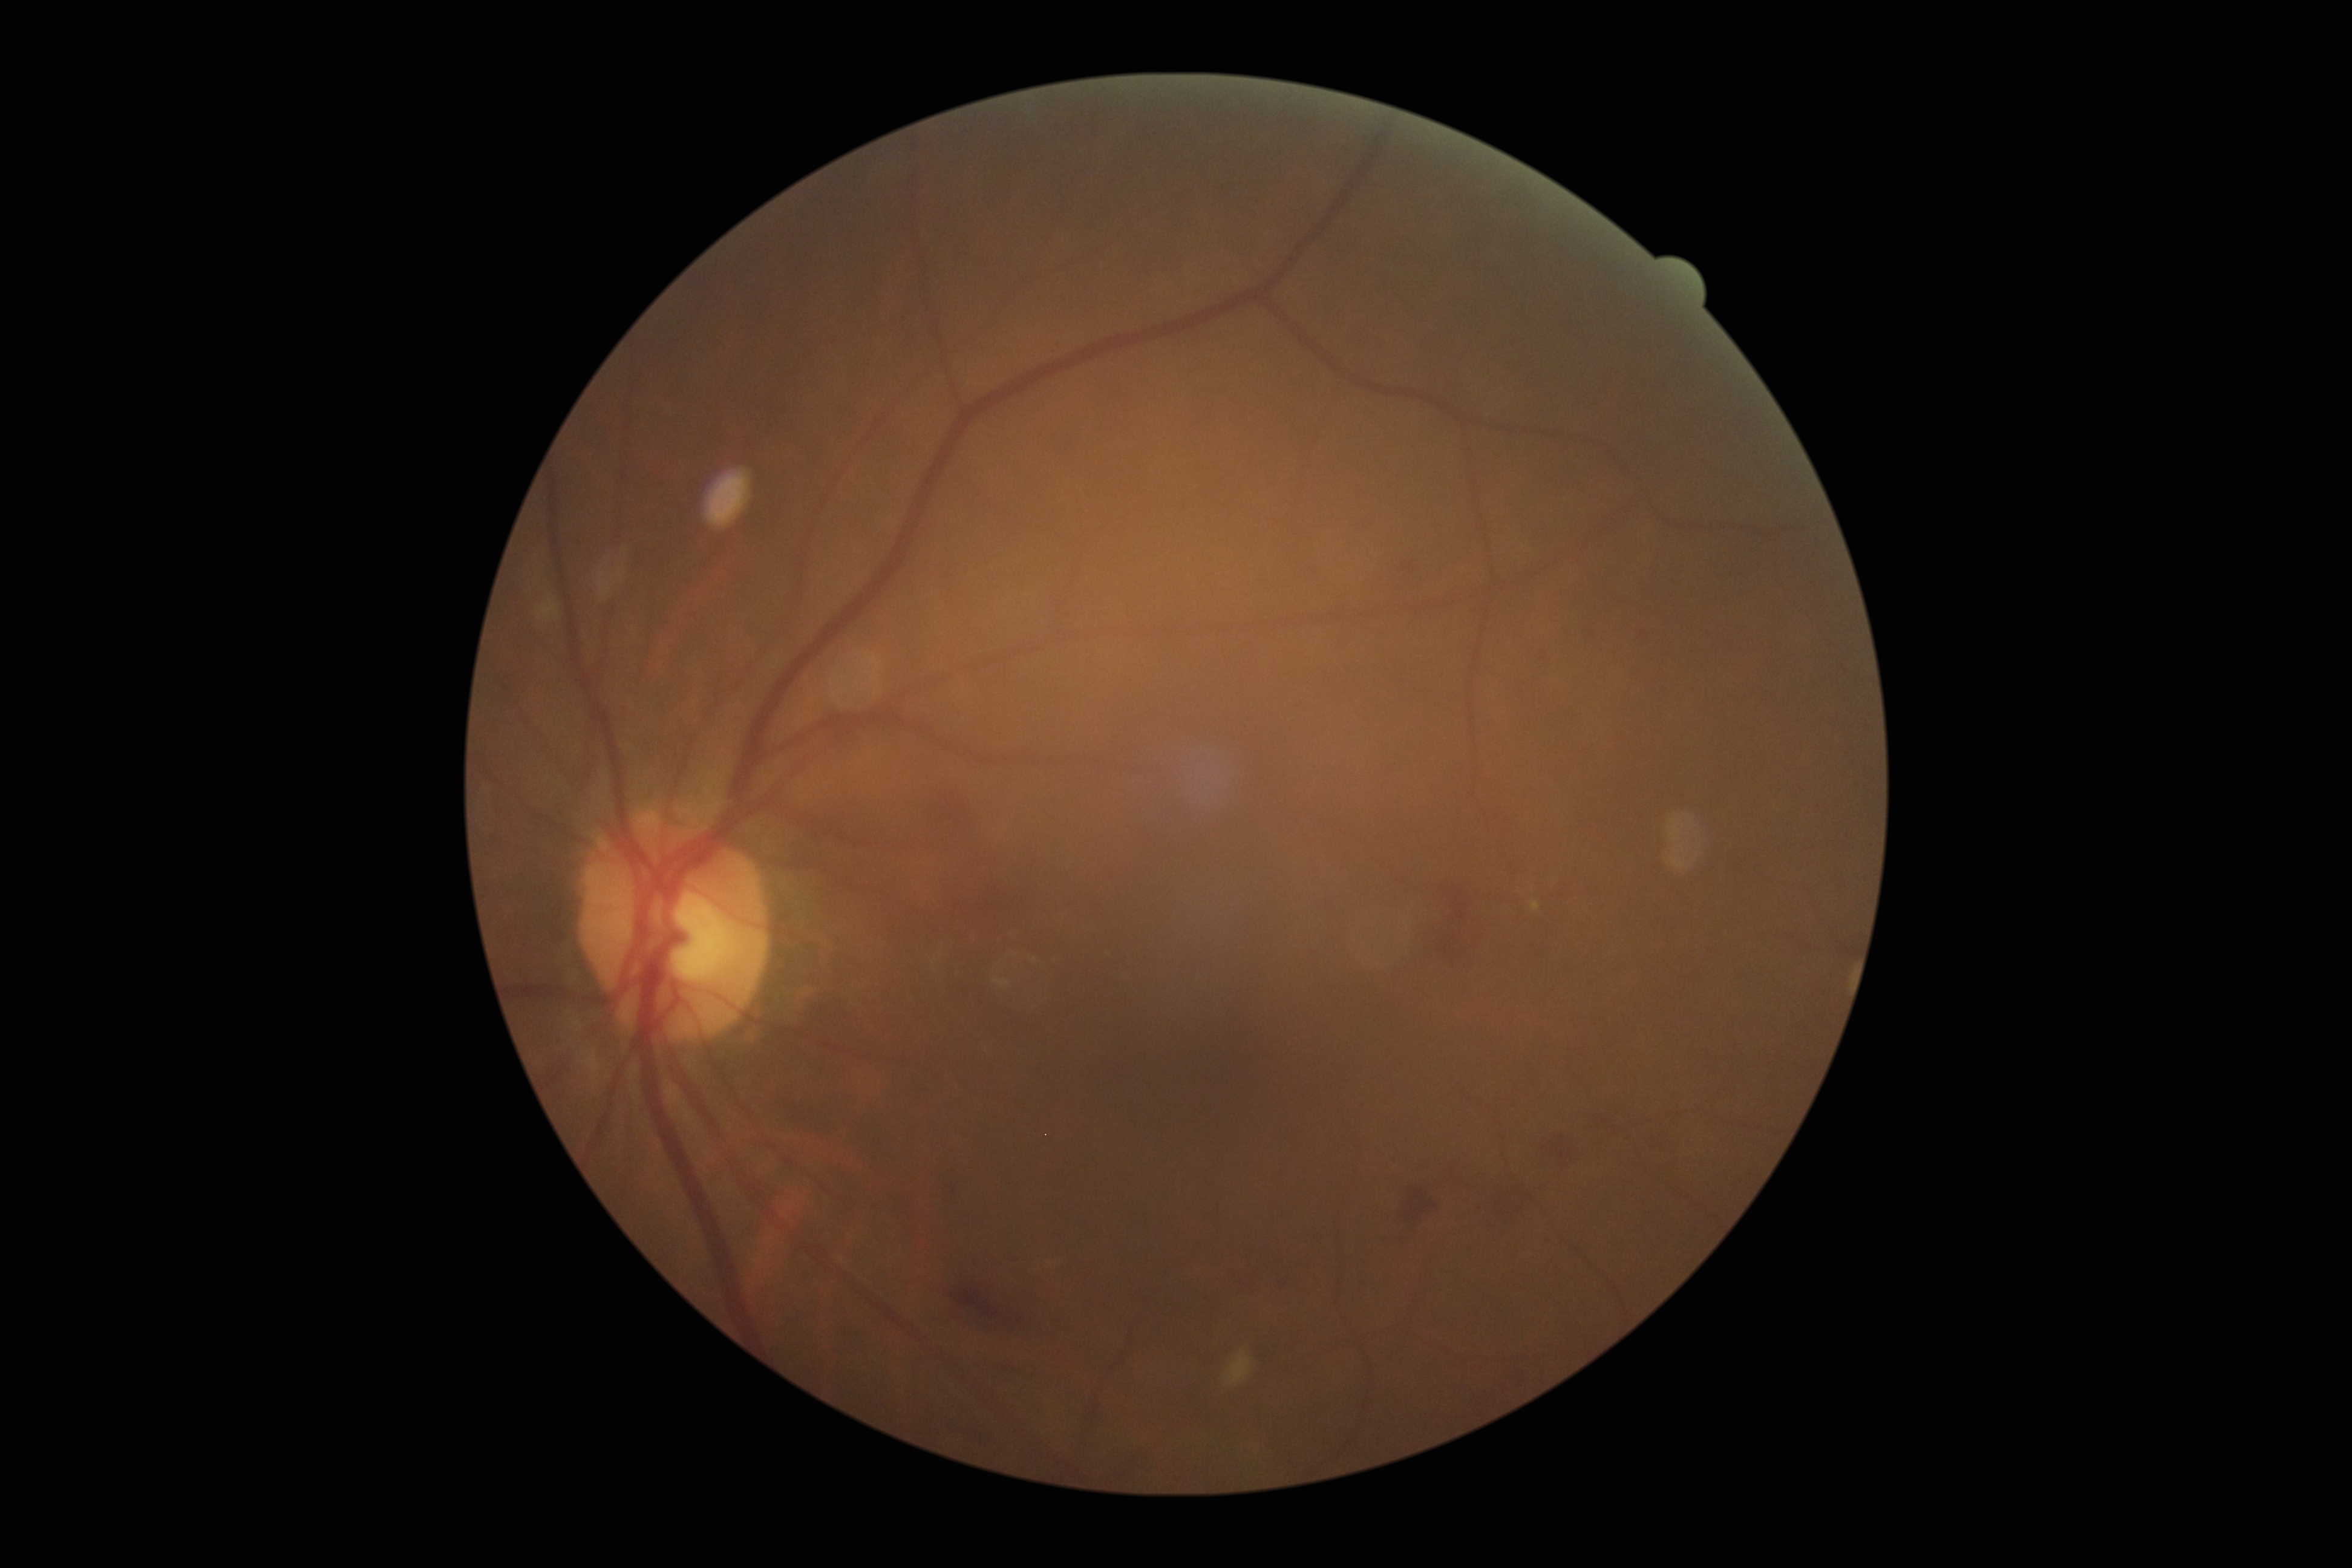 DR stage is 2 — more than just microaneurysms but less than severe NPDR. Disease class: non-proliferative diabetic retinopathy.